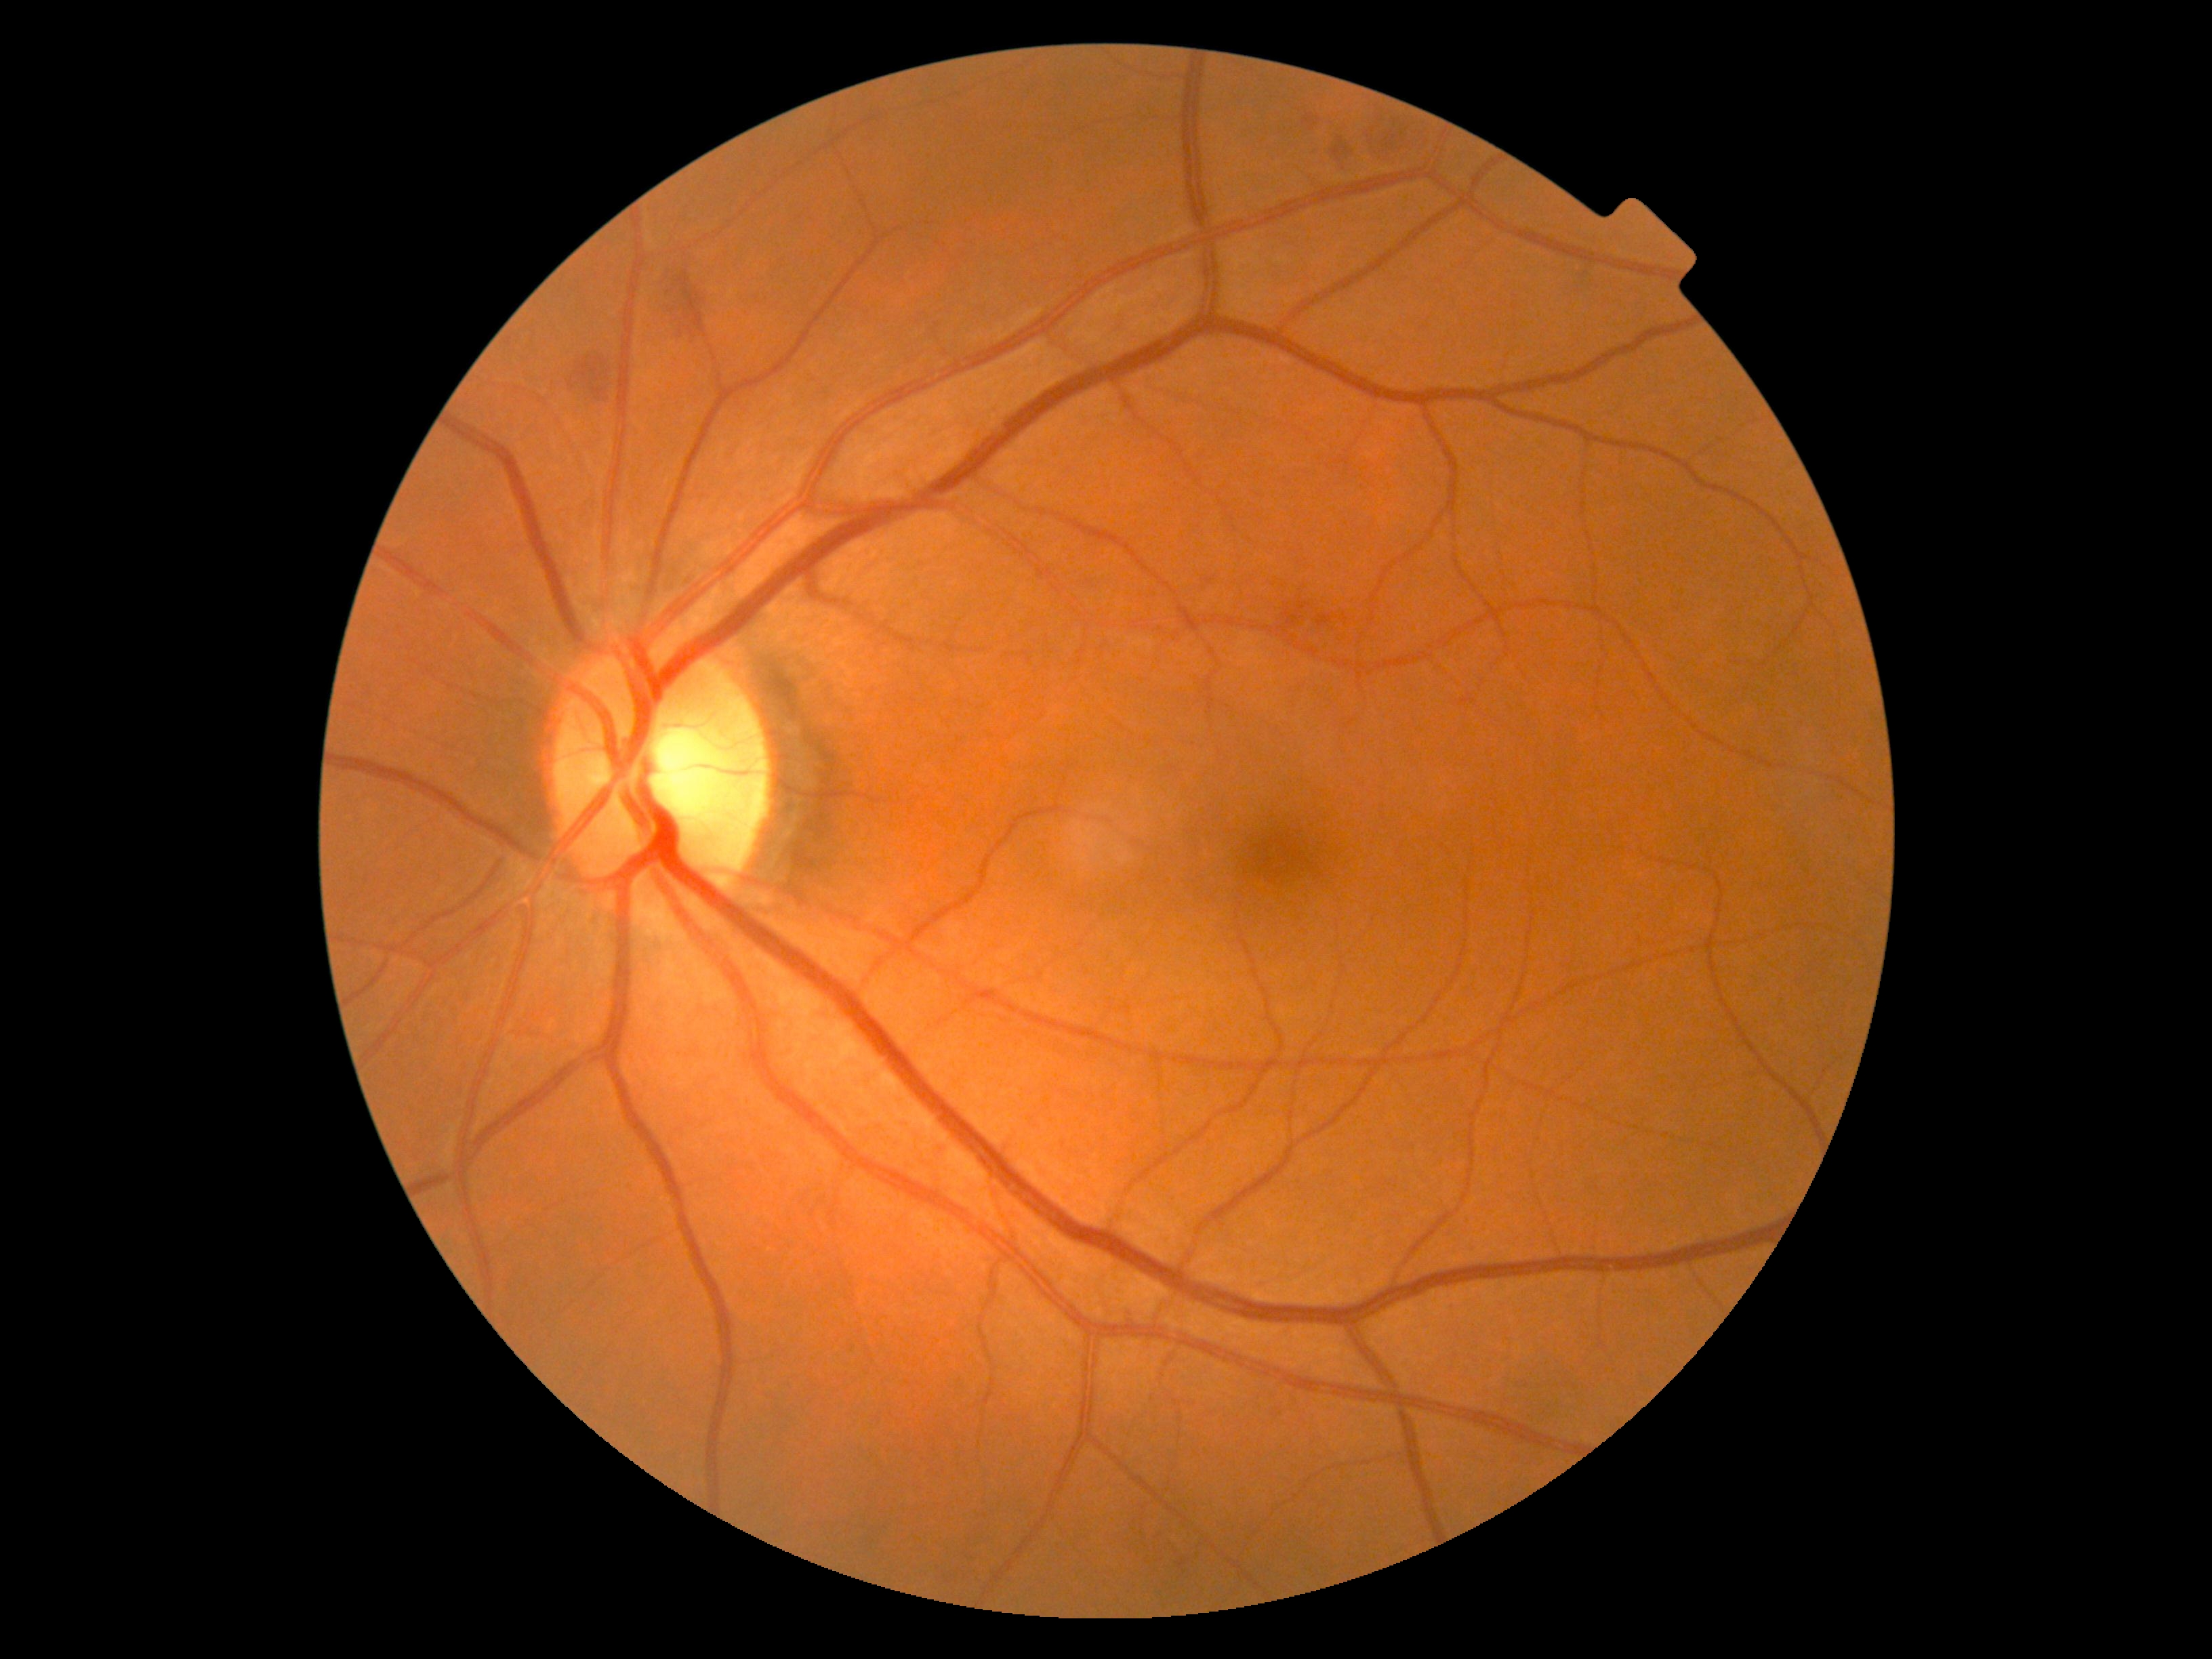 - DR — 2/4